Color fundus image · FOV: 45 degrees · 2346 by 1568 pixels
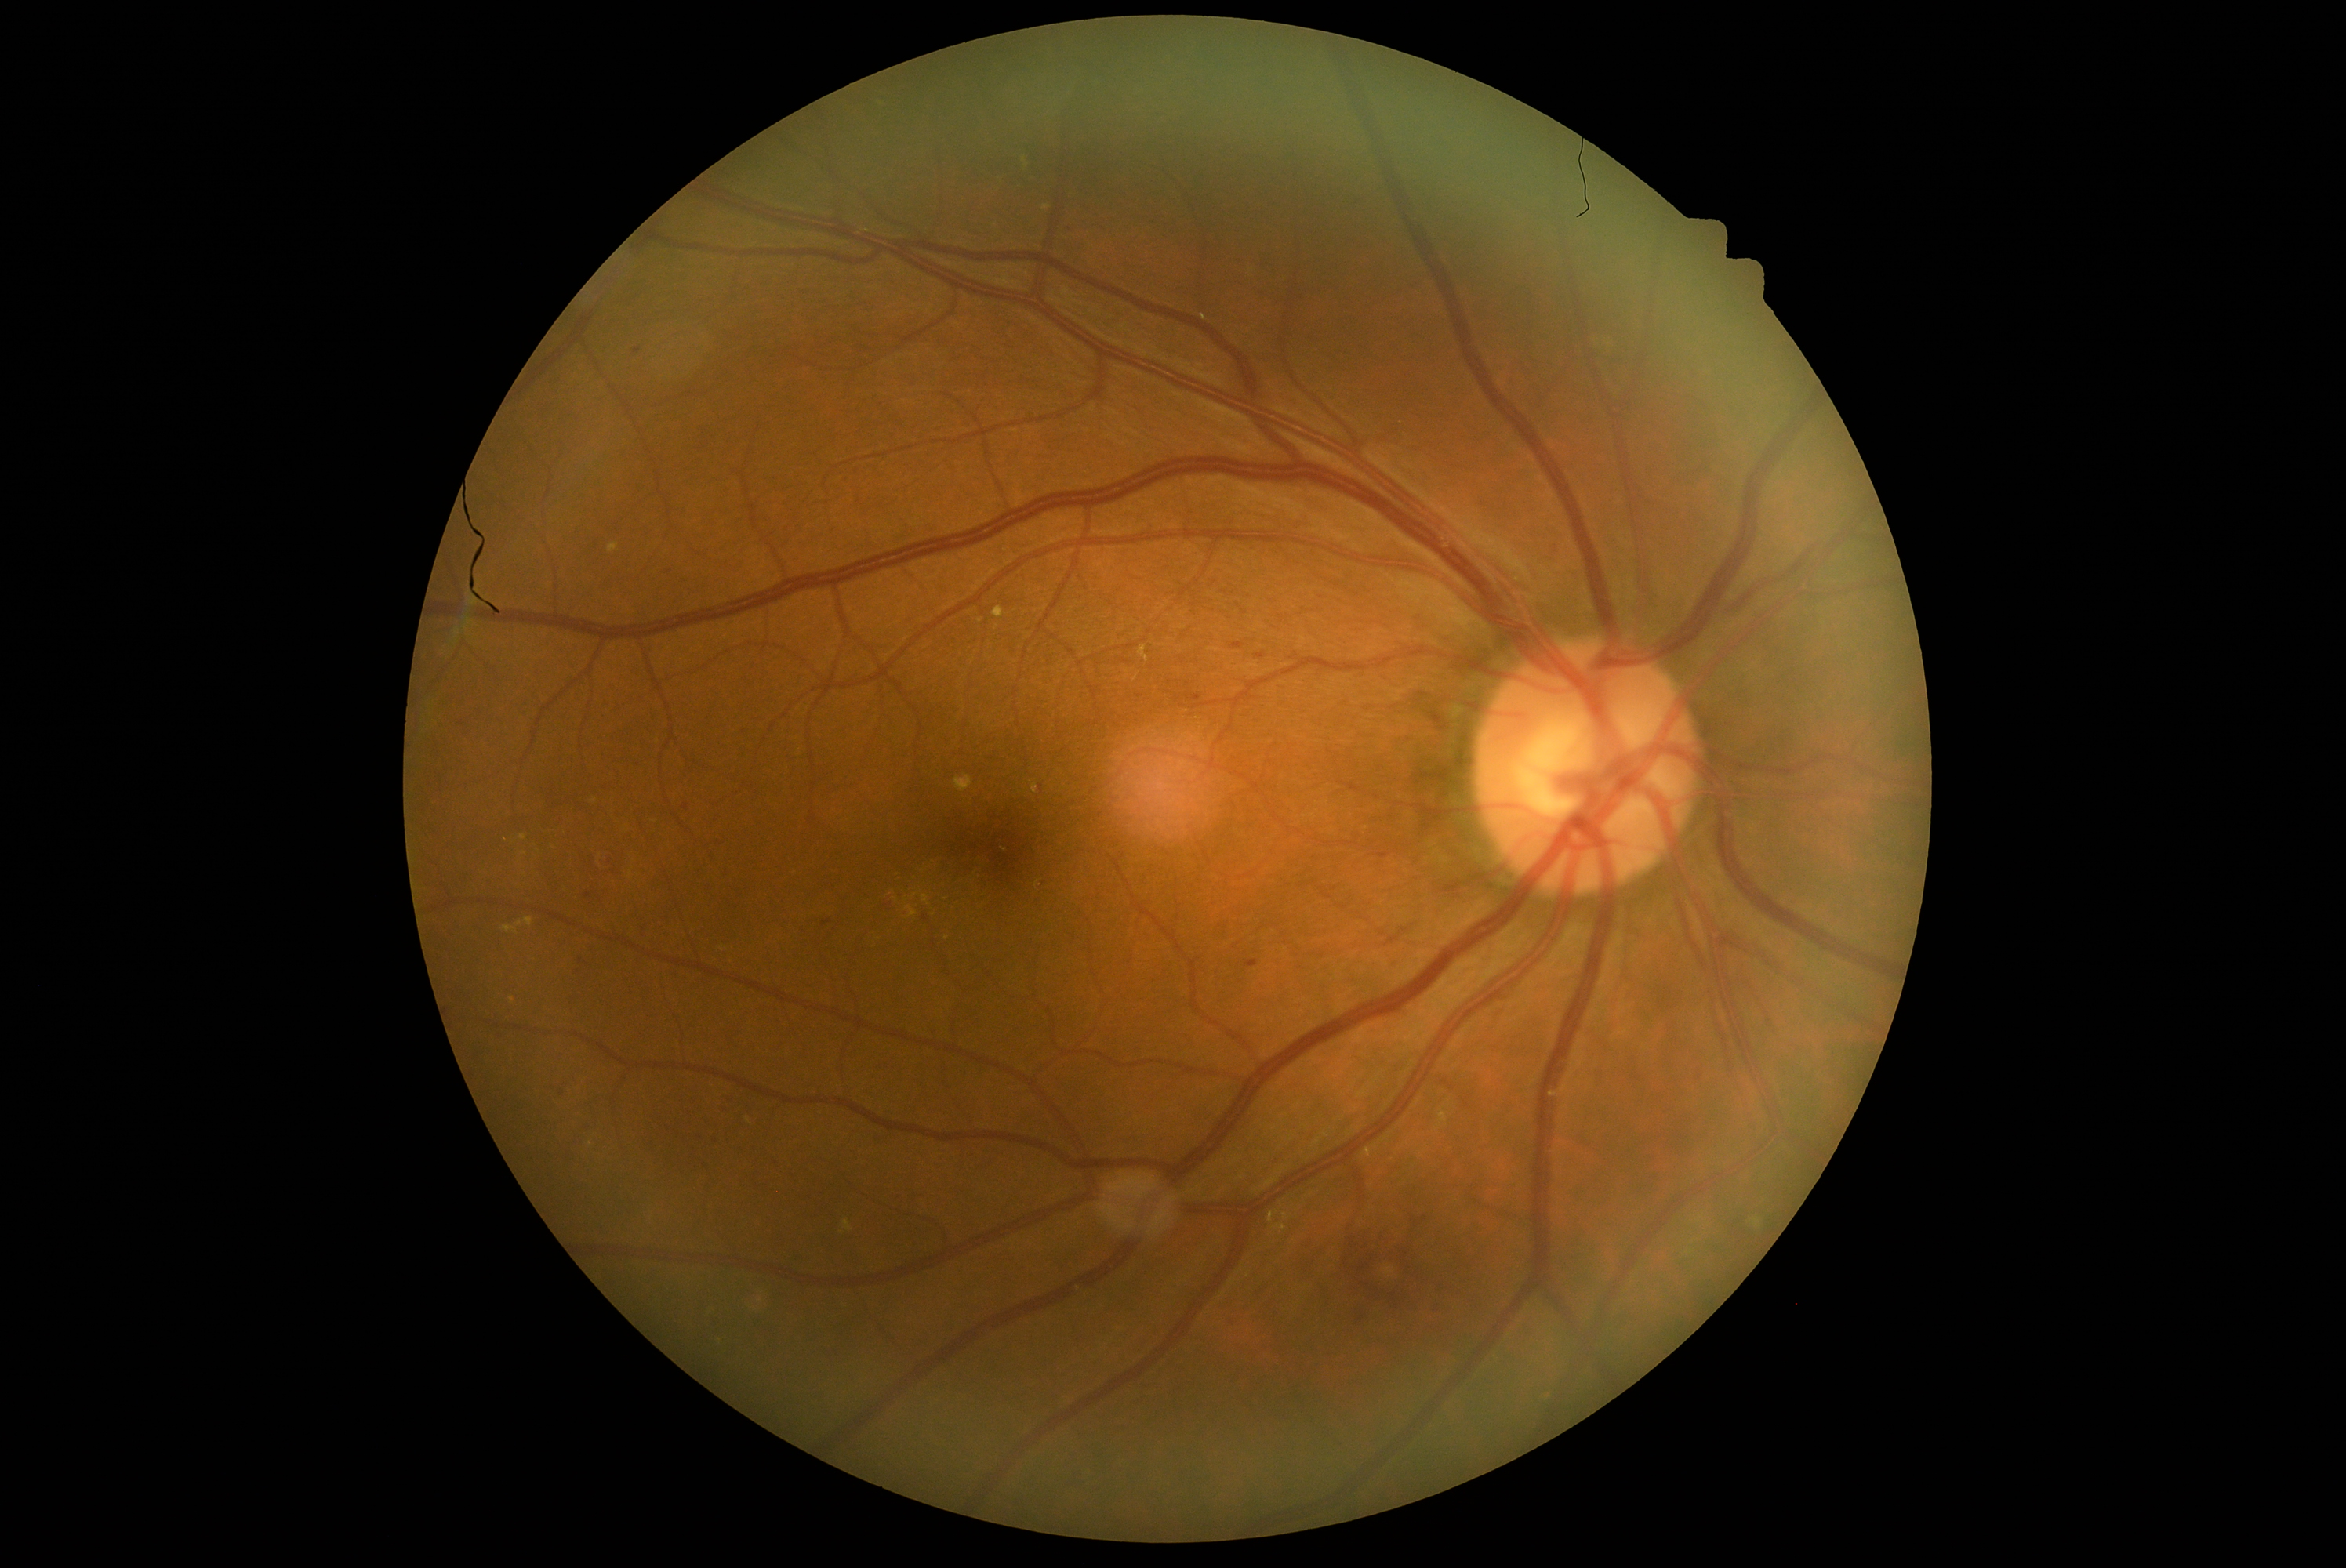
diabetic retinopathy grade = 2/4